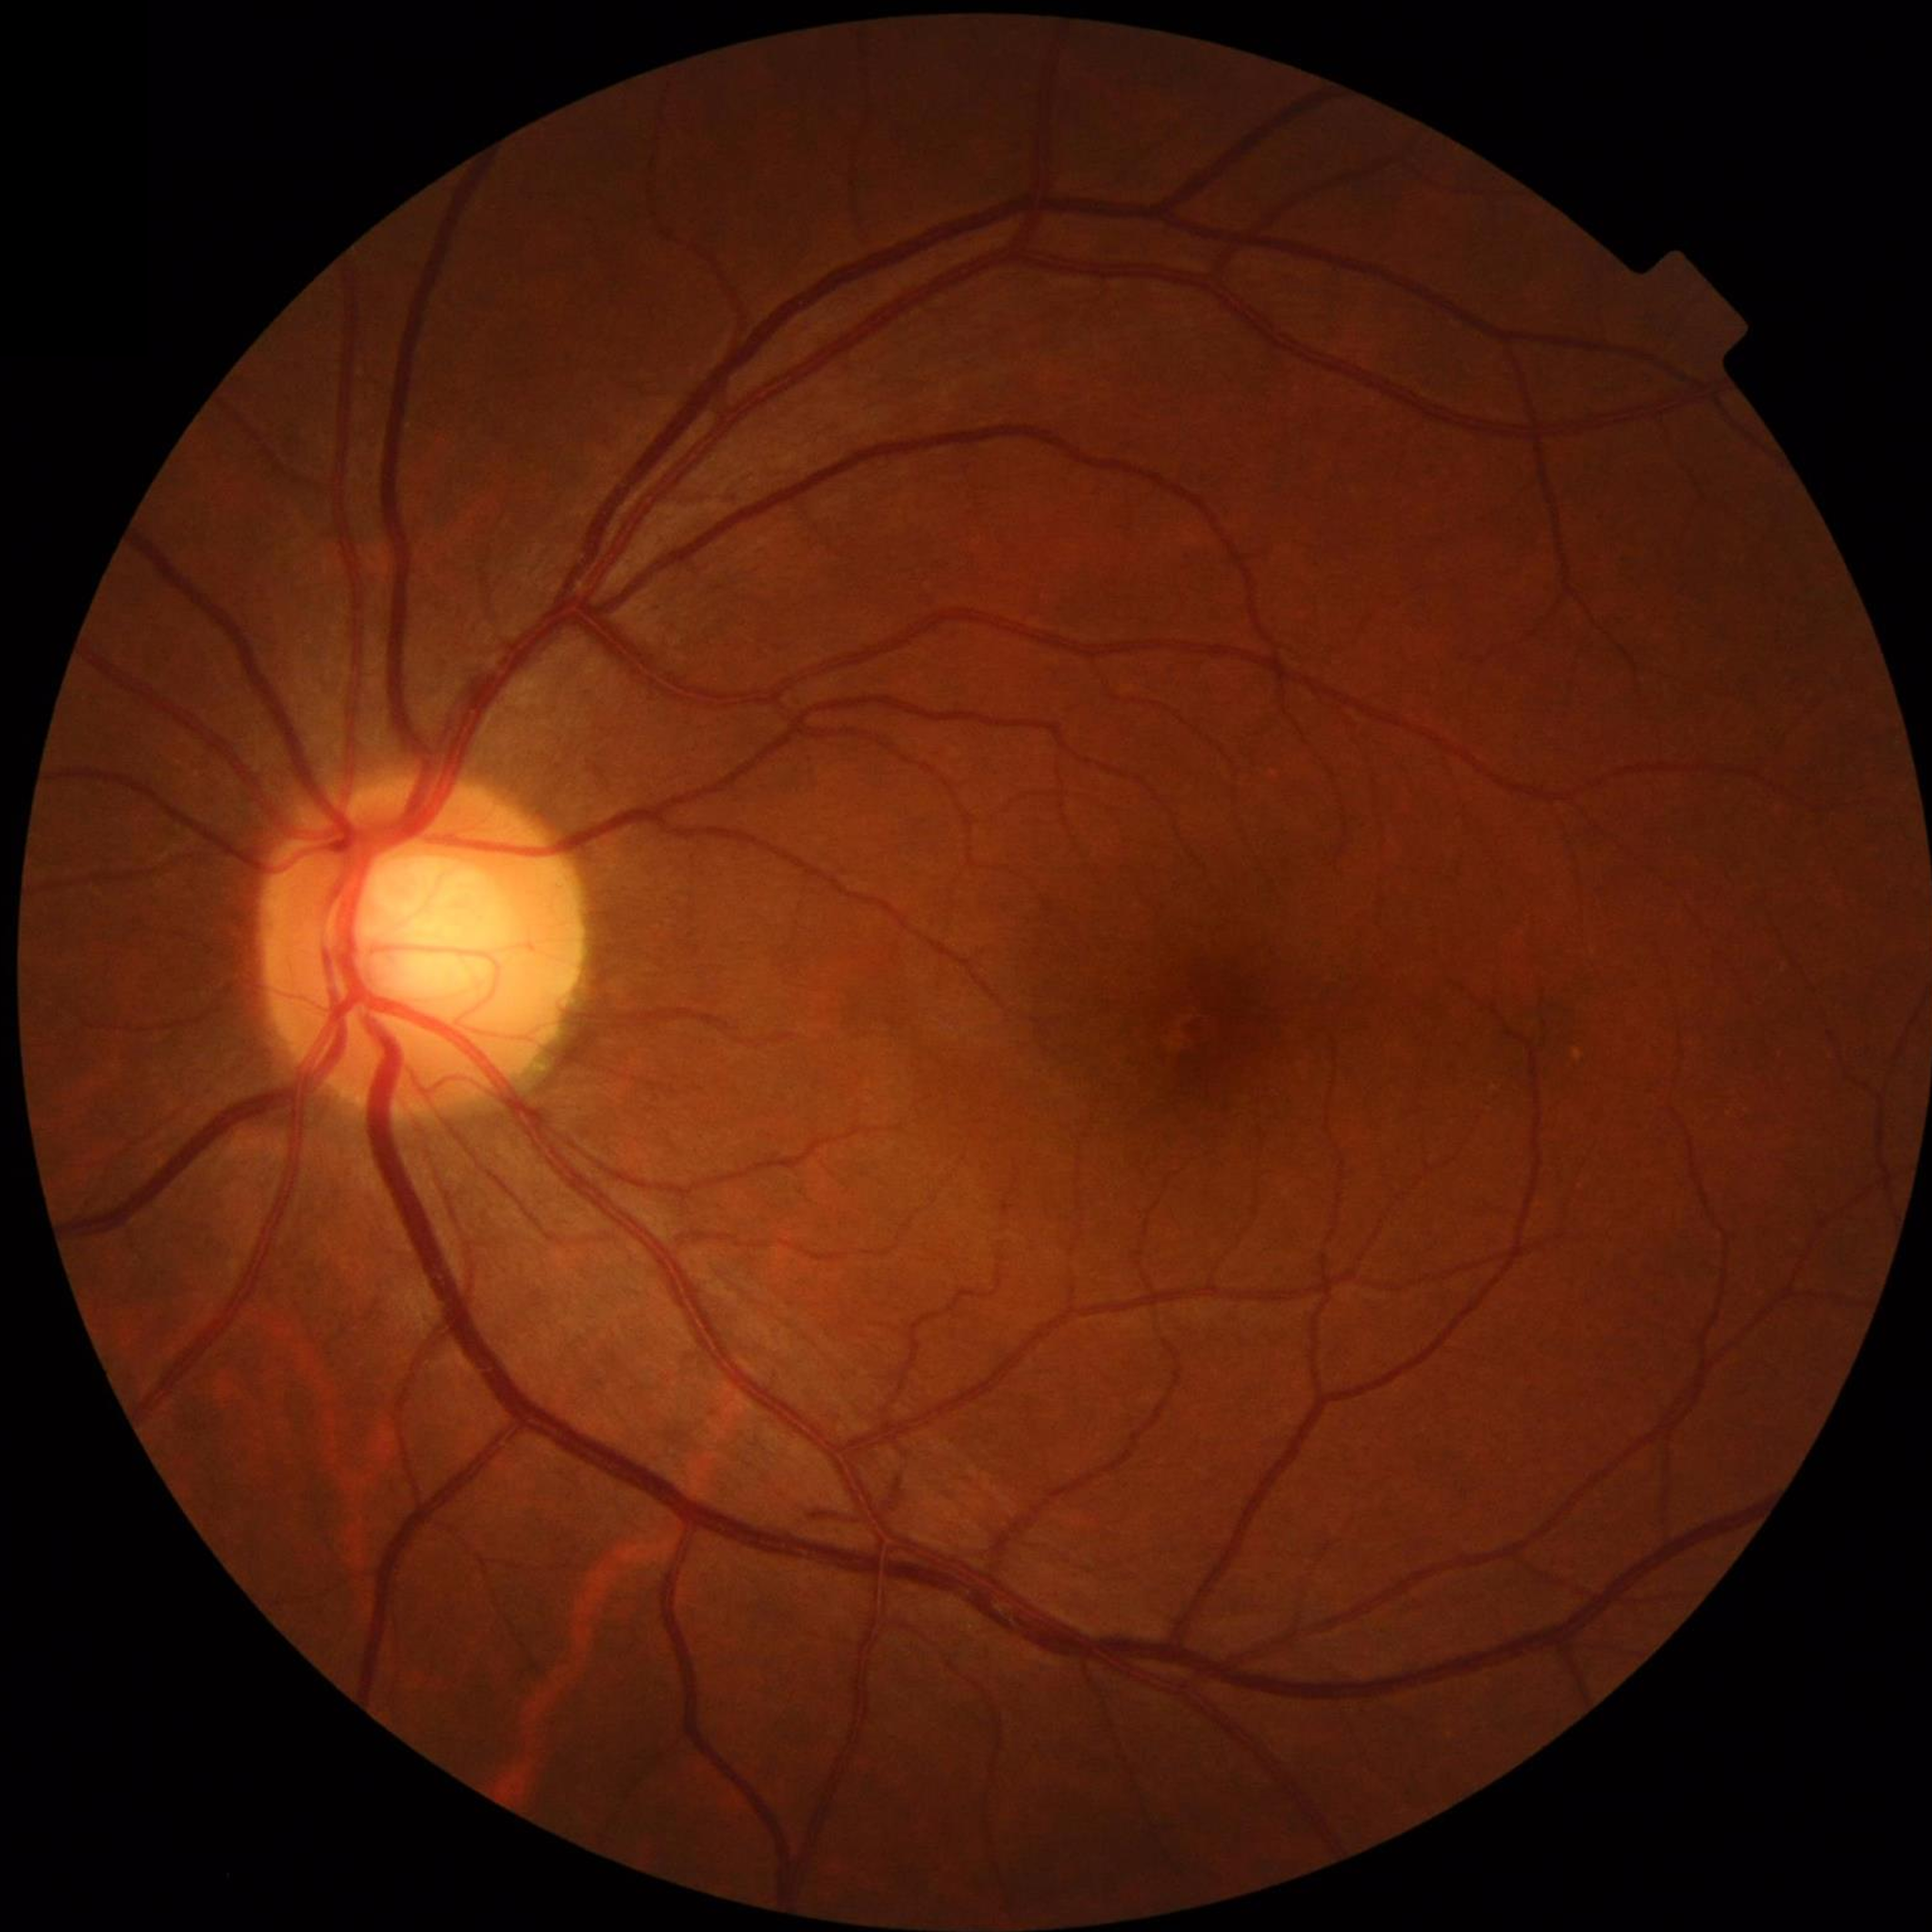

Condition: no AMD, DR, or glaucomatous findings.